Camera: Nidek AFC-330
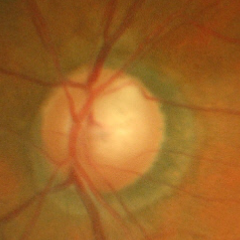 Q: Glaucoma assessment?
A: Early glaucomatous optic neuropathy.